Image size 1240x1240 · pediatric retinal photograph (wide-field).
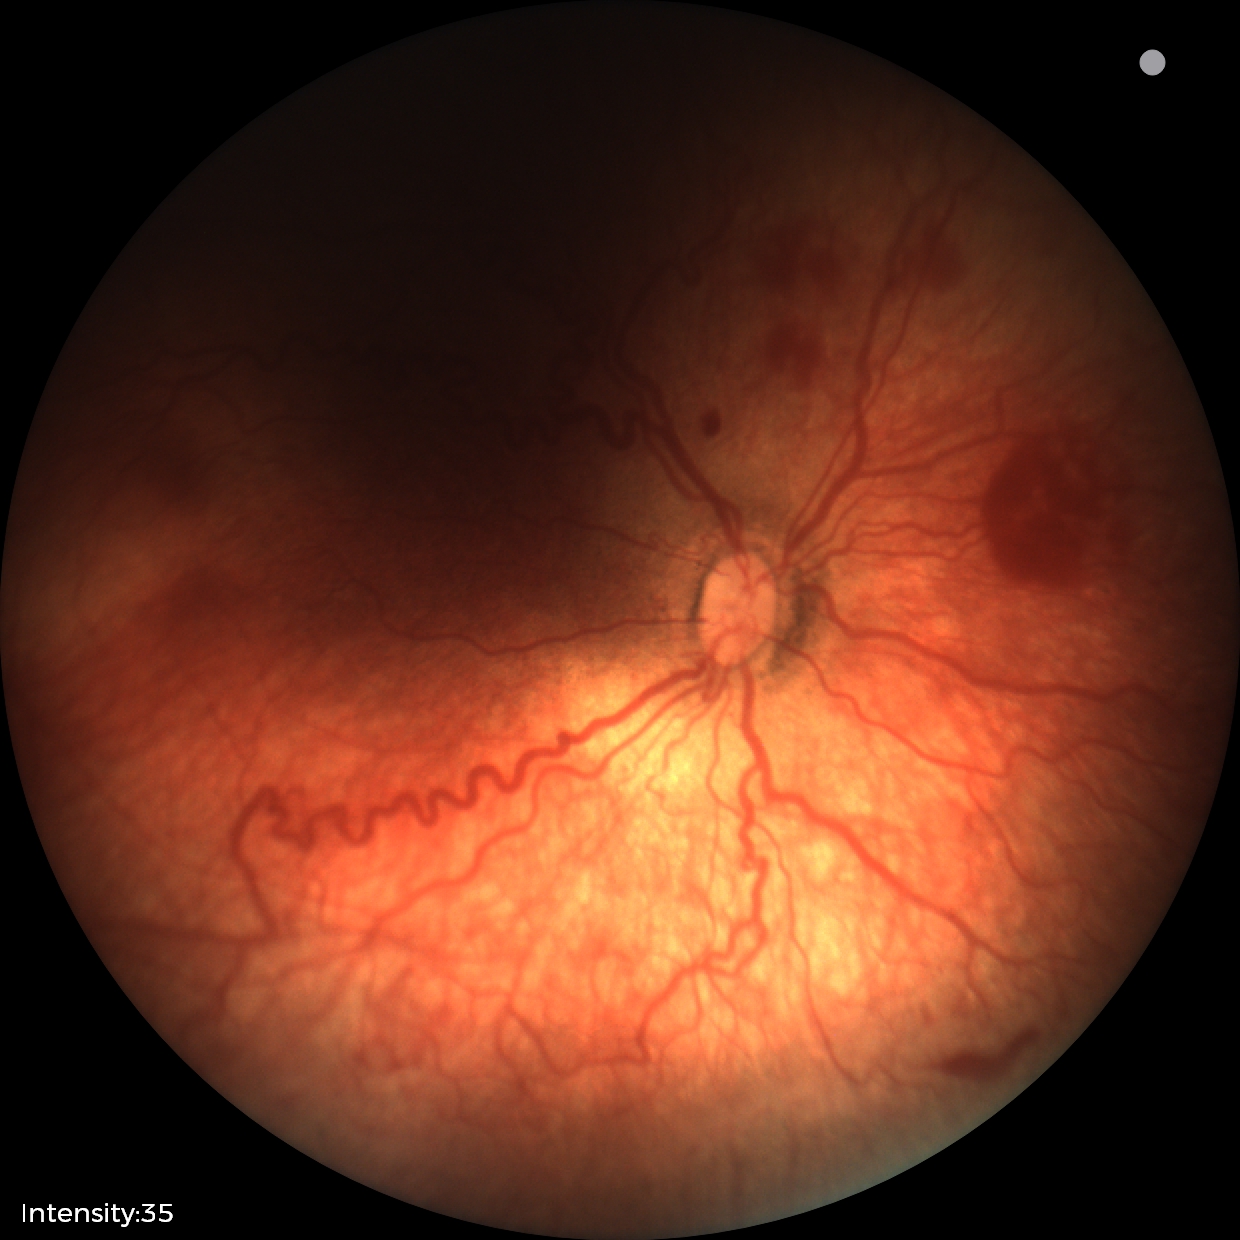

Plus disease was diagnosed.
Series diagnosed as ROP stage 2.